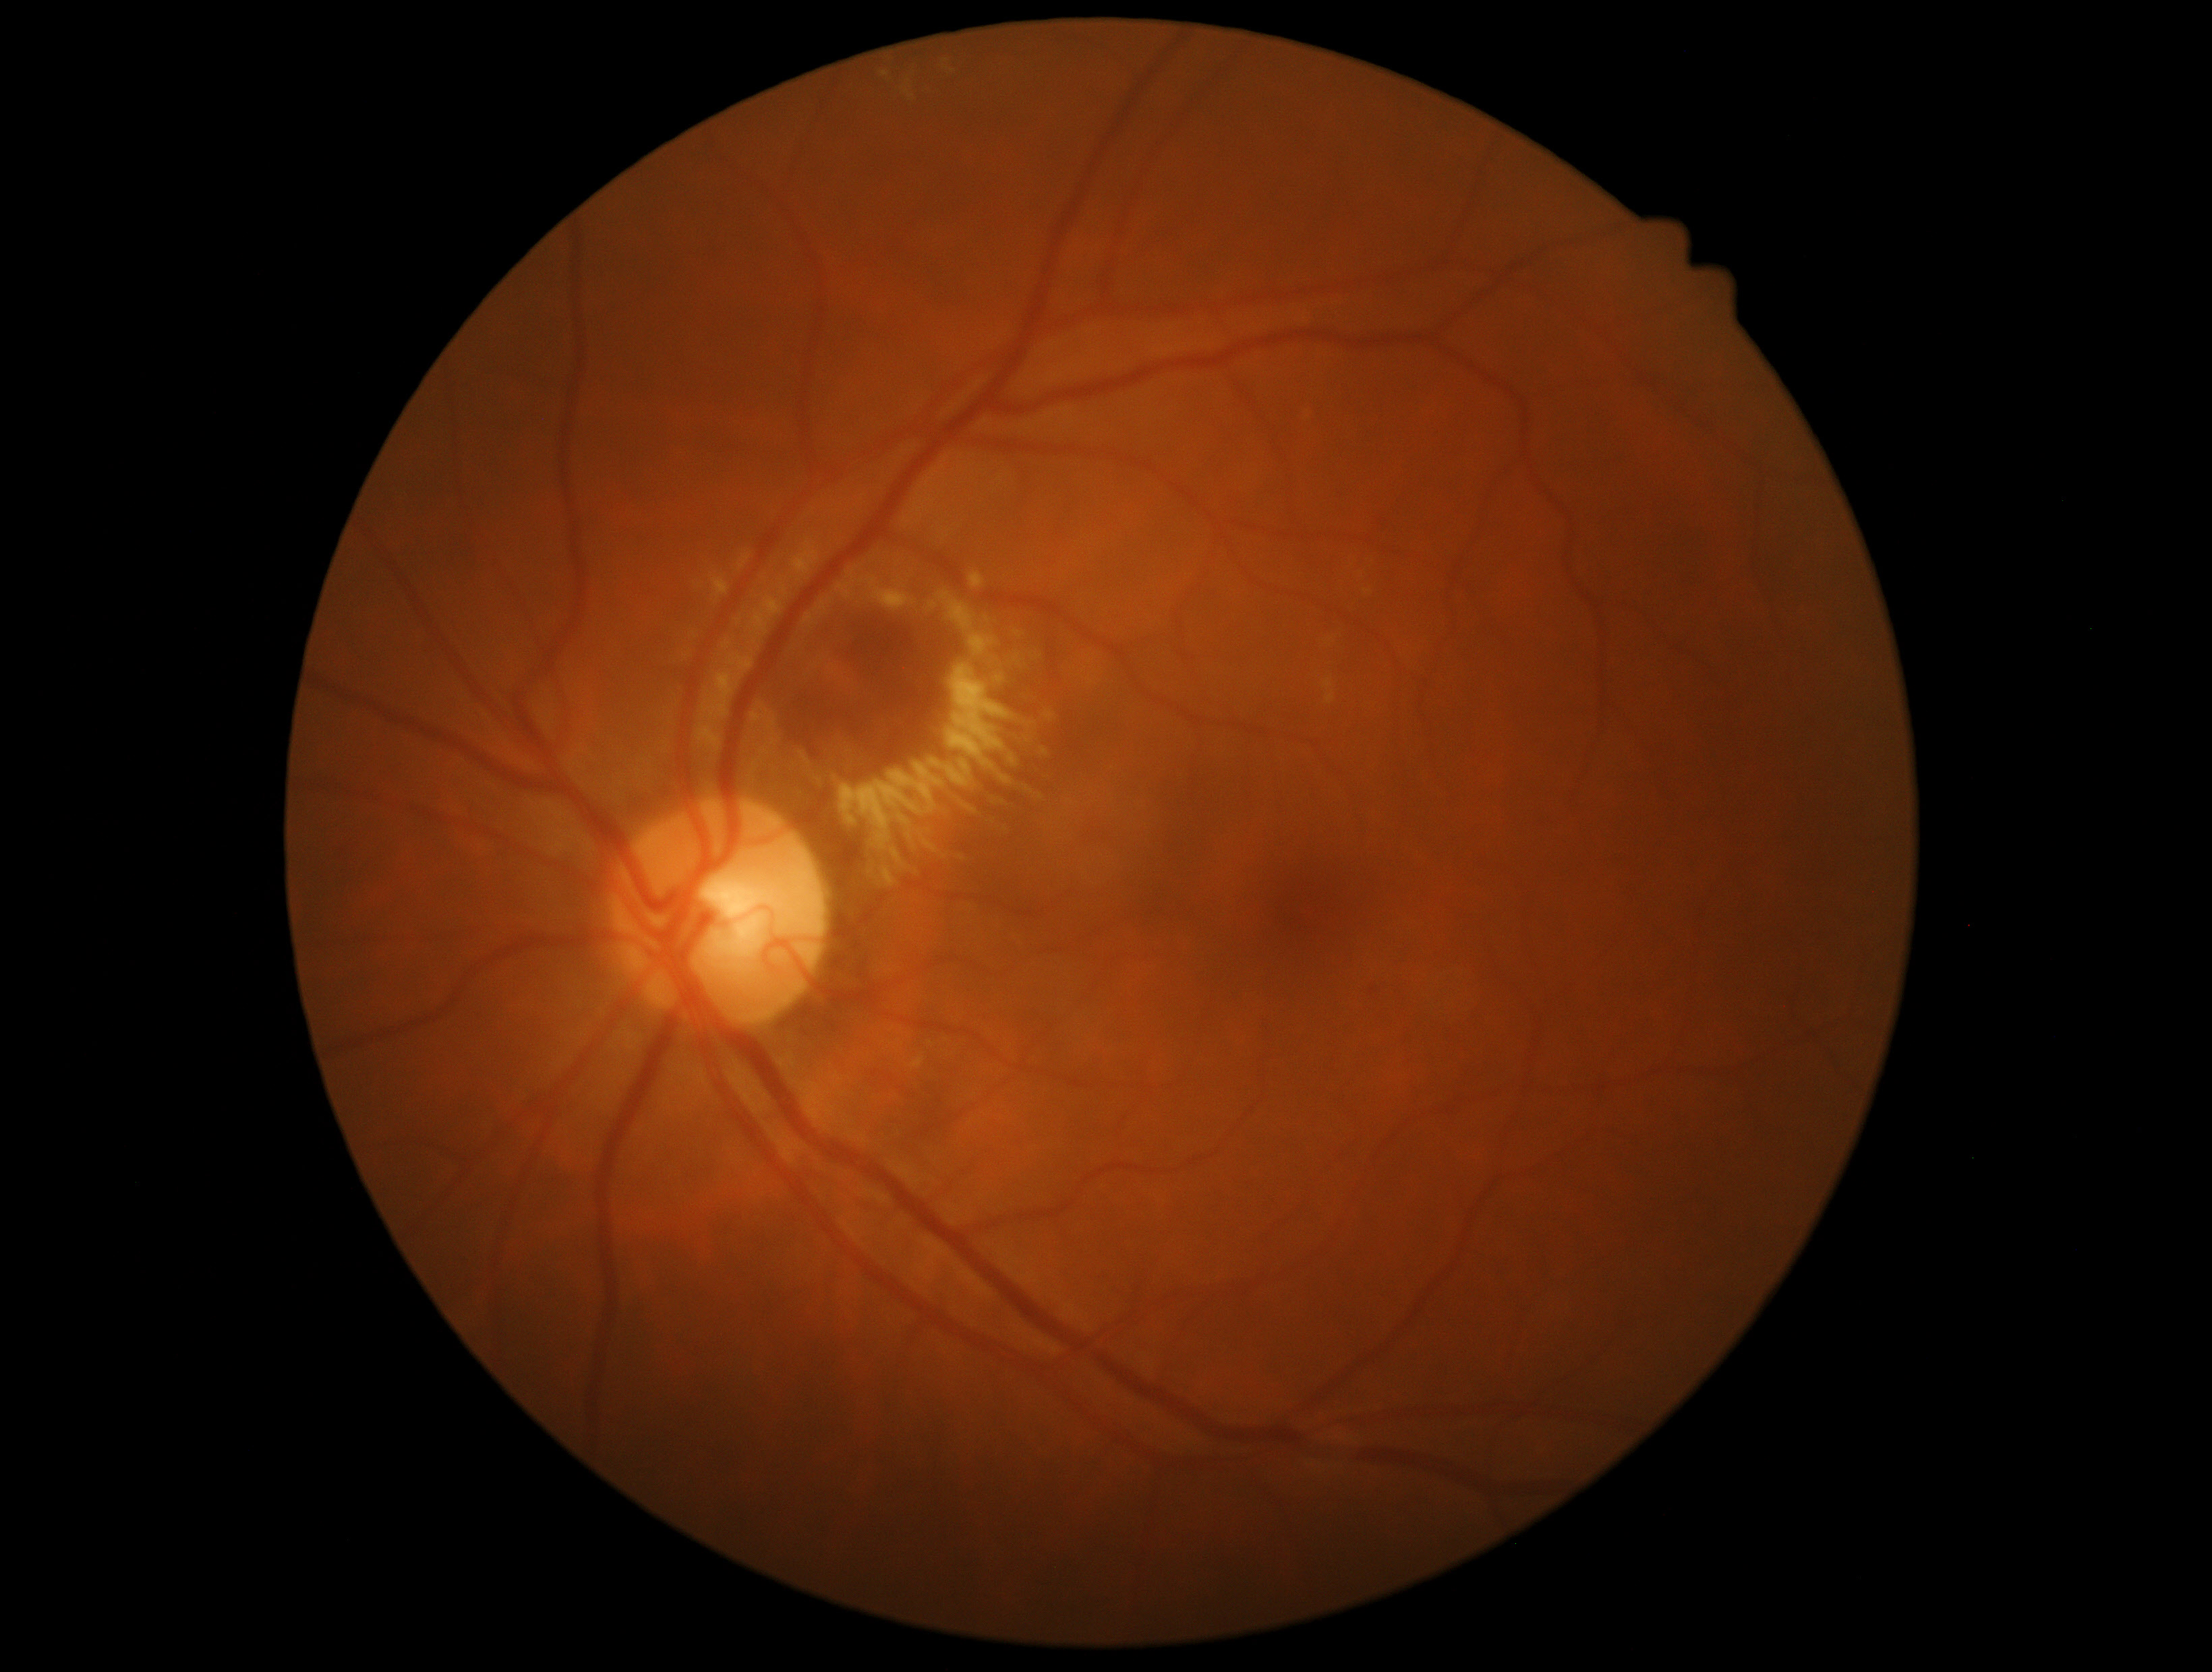
Diabetic retinopathy (DR) is 2/4.